FOV: 45 degrees, 2184x1690, CFP: 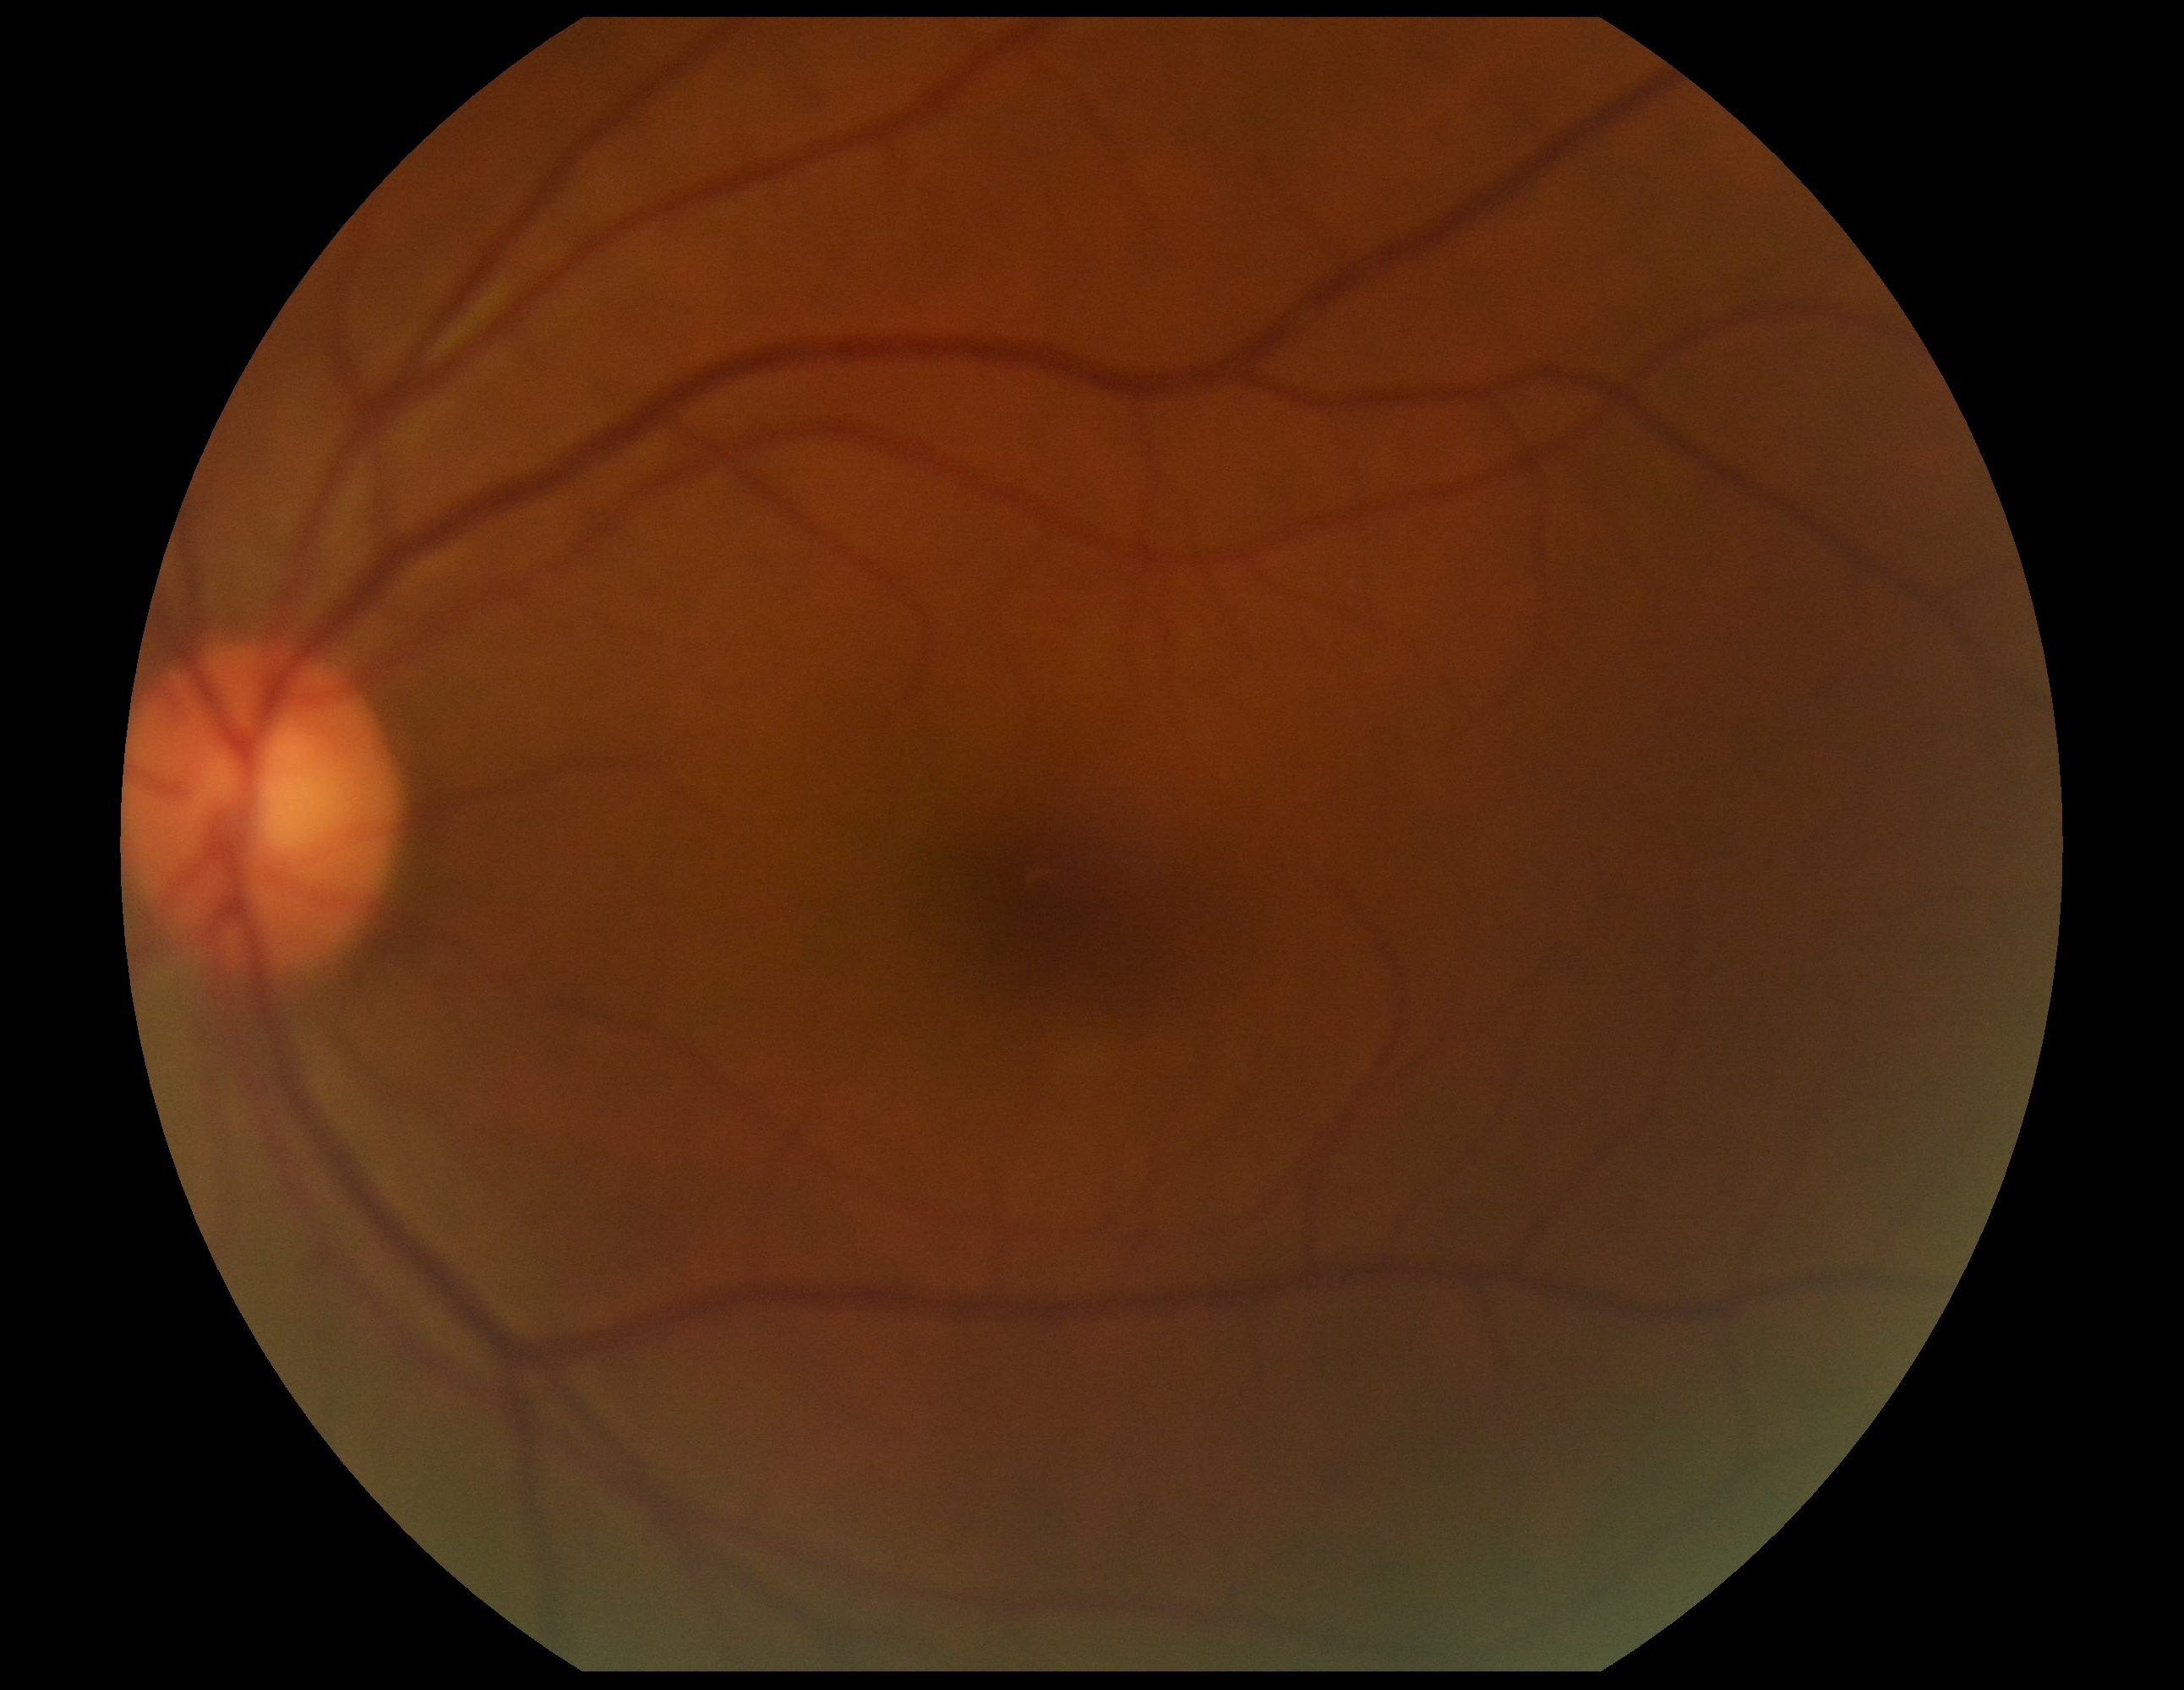
No apparent diabetic retinopathy. Retinopathy grade: 0 (no apparent retinopathy).